45 degree fundus photograph: 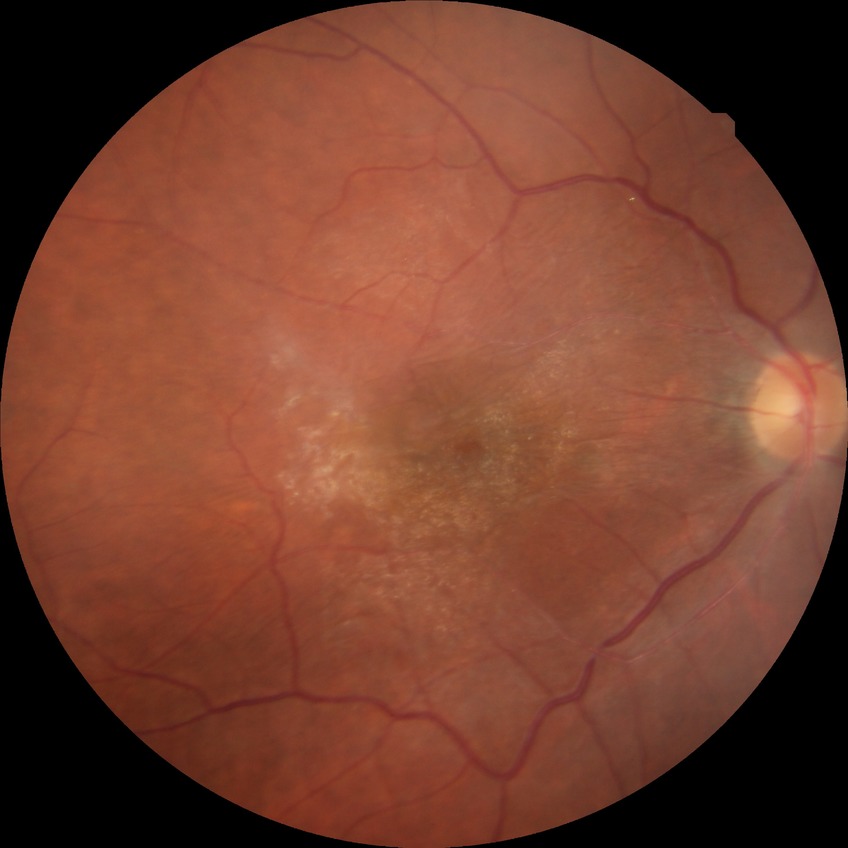
Diabetic retinopathy (DR) is NDR (no diabetic retinopathy).